Acquired with a NIDEK AFC-230 — 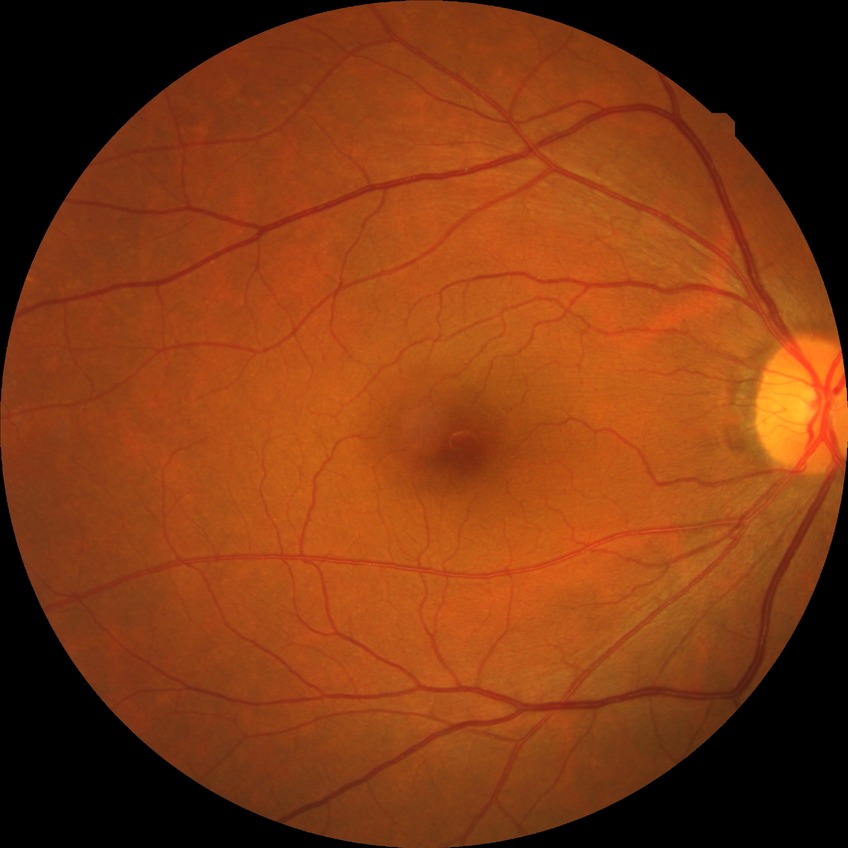
retinopathy stage: no diabetic retinopathy.